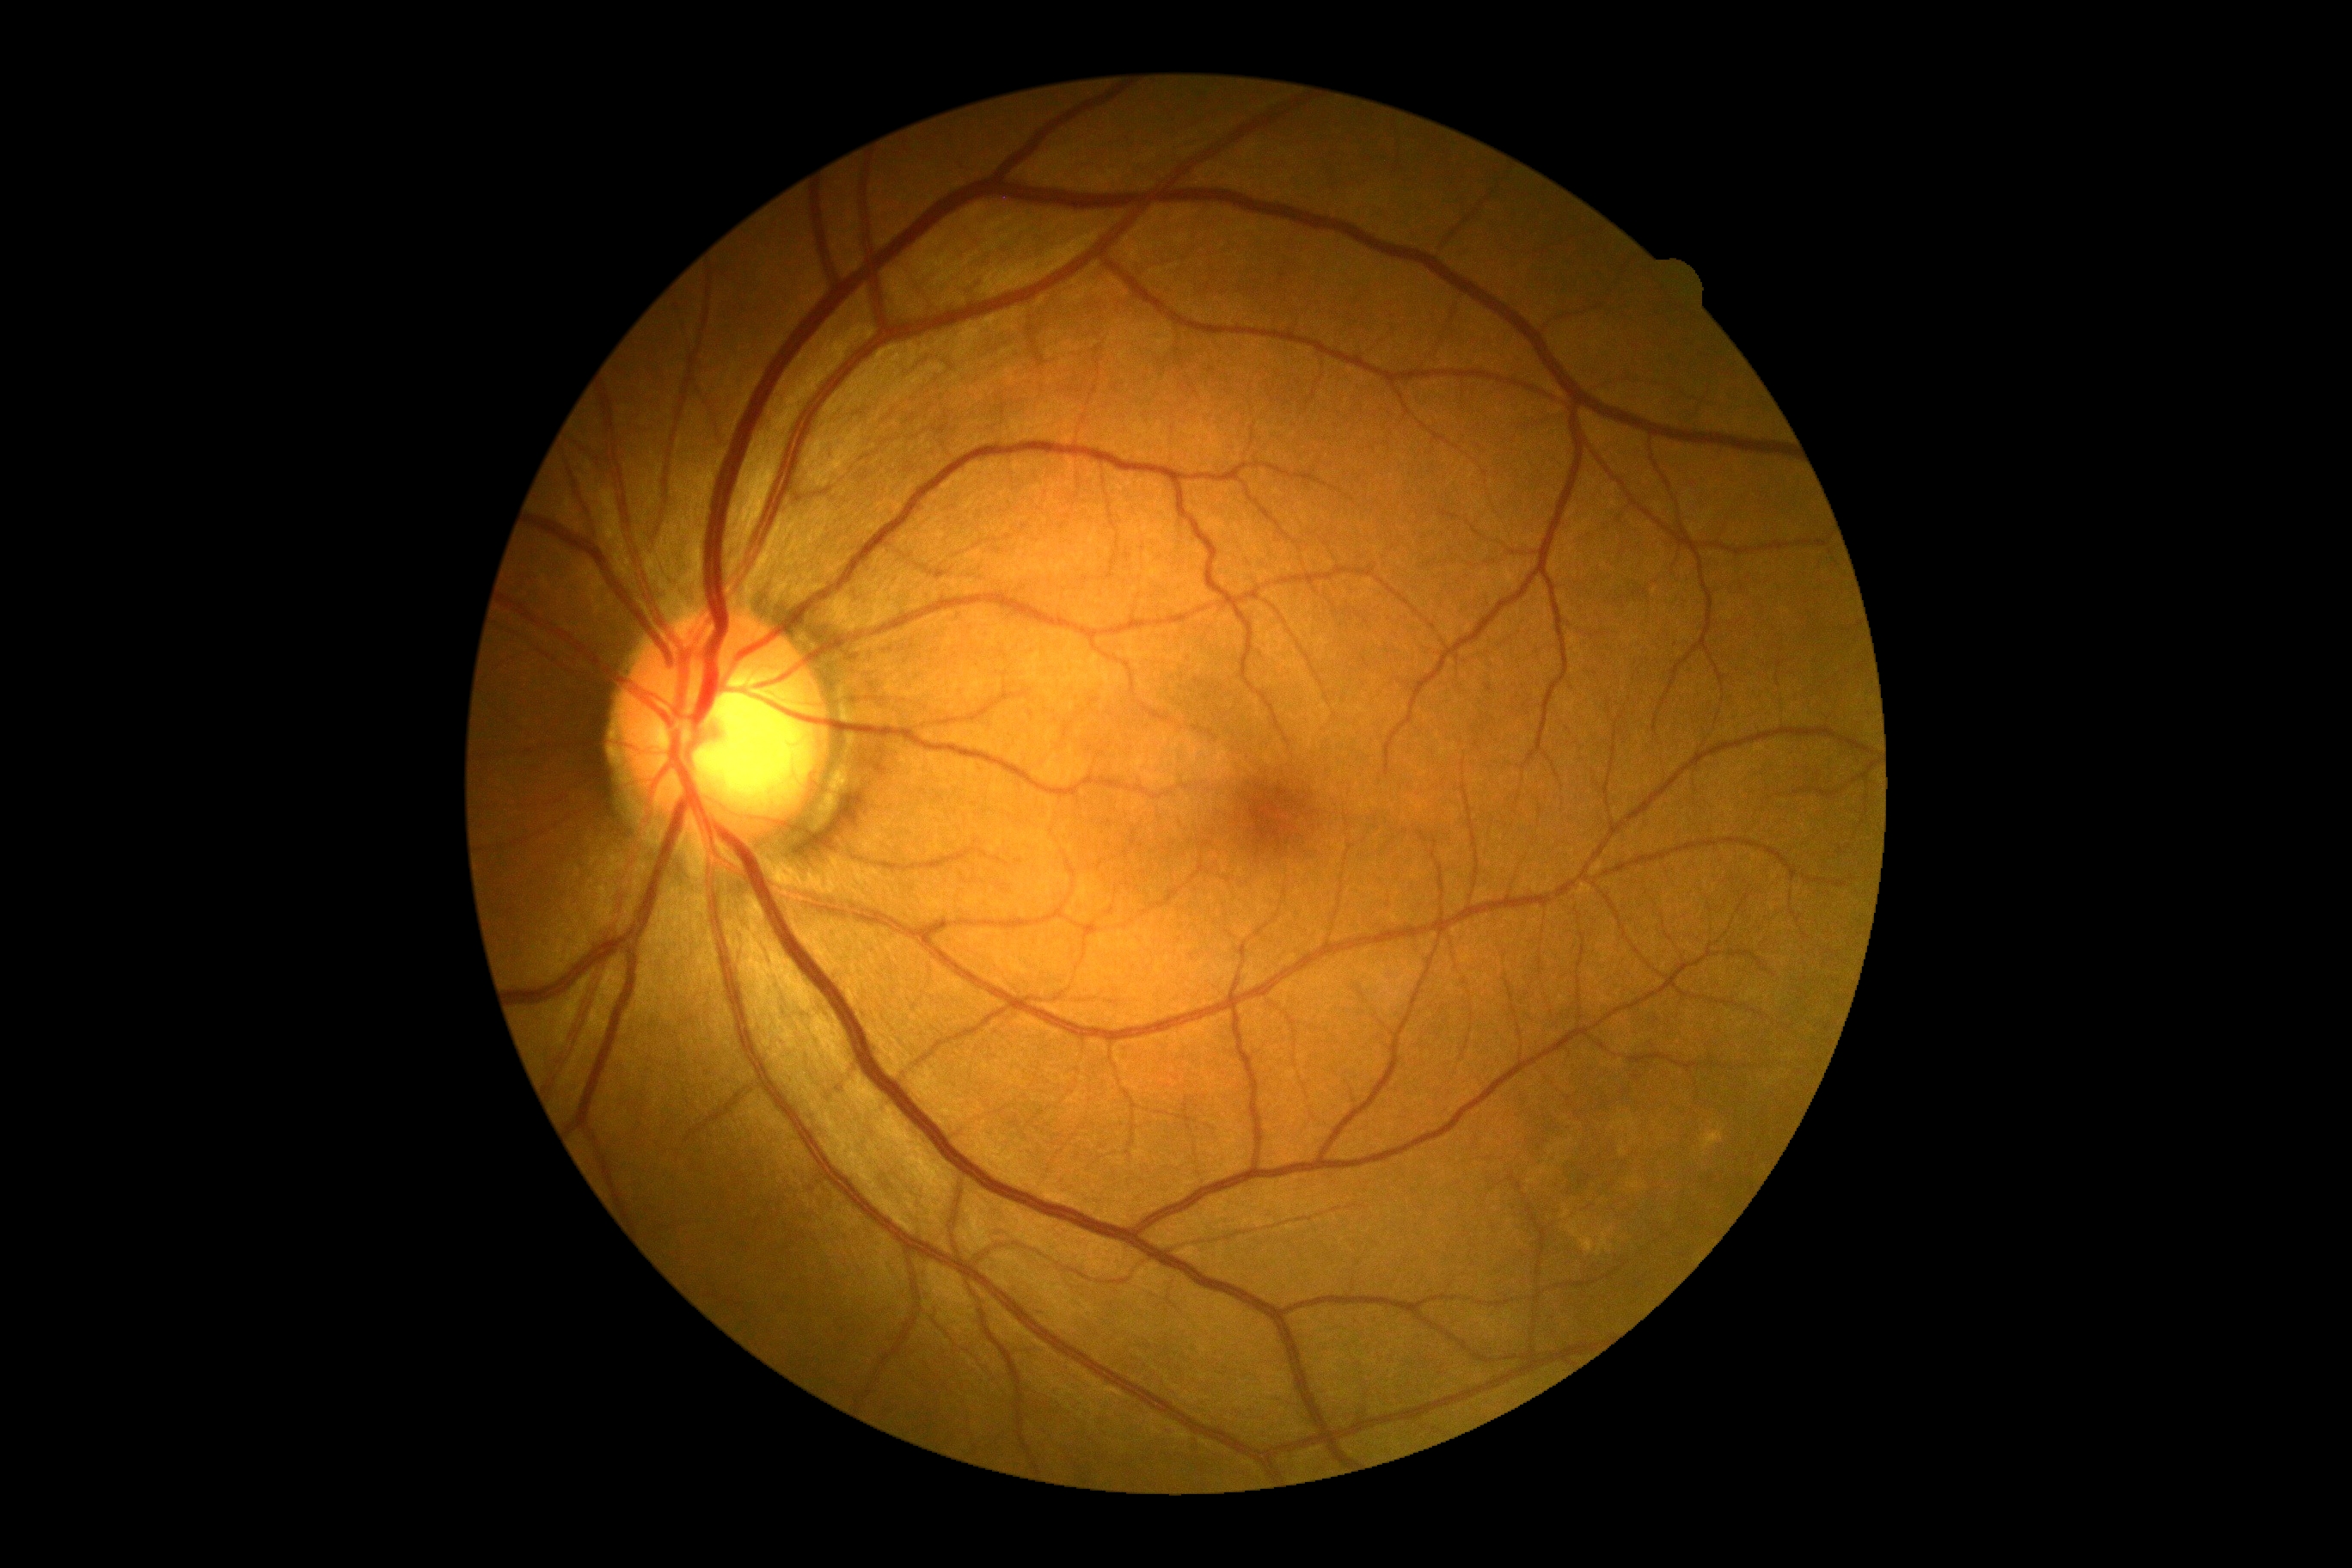

diabetic retinopathy (DR): 0, DR impression: no apparent DR.